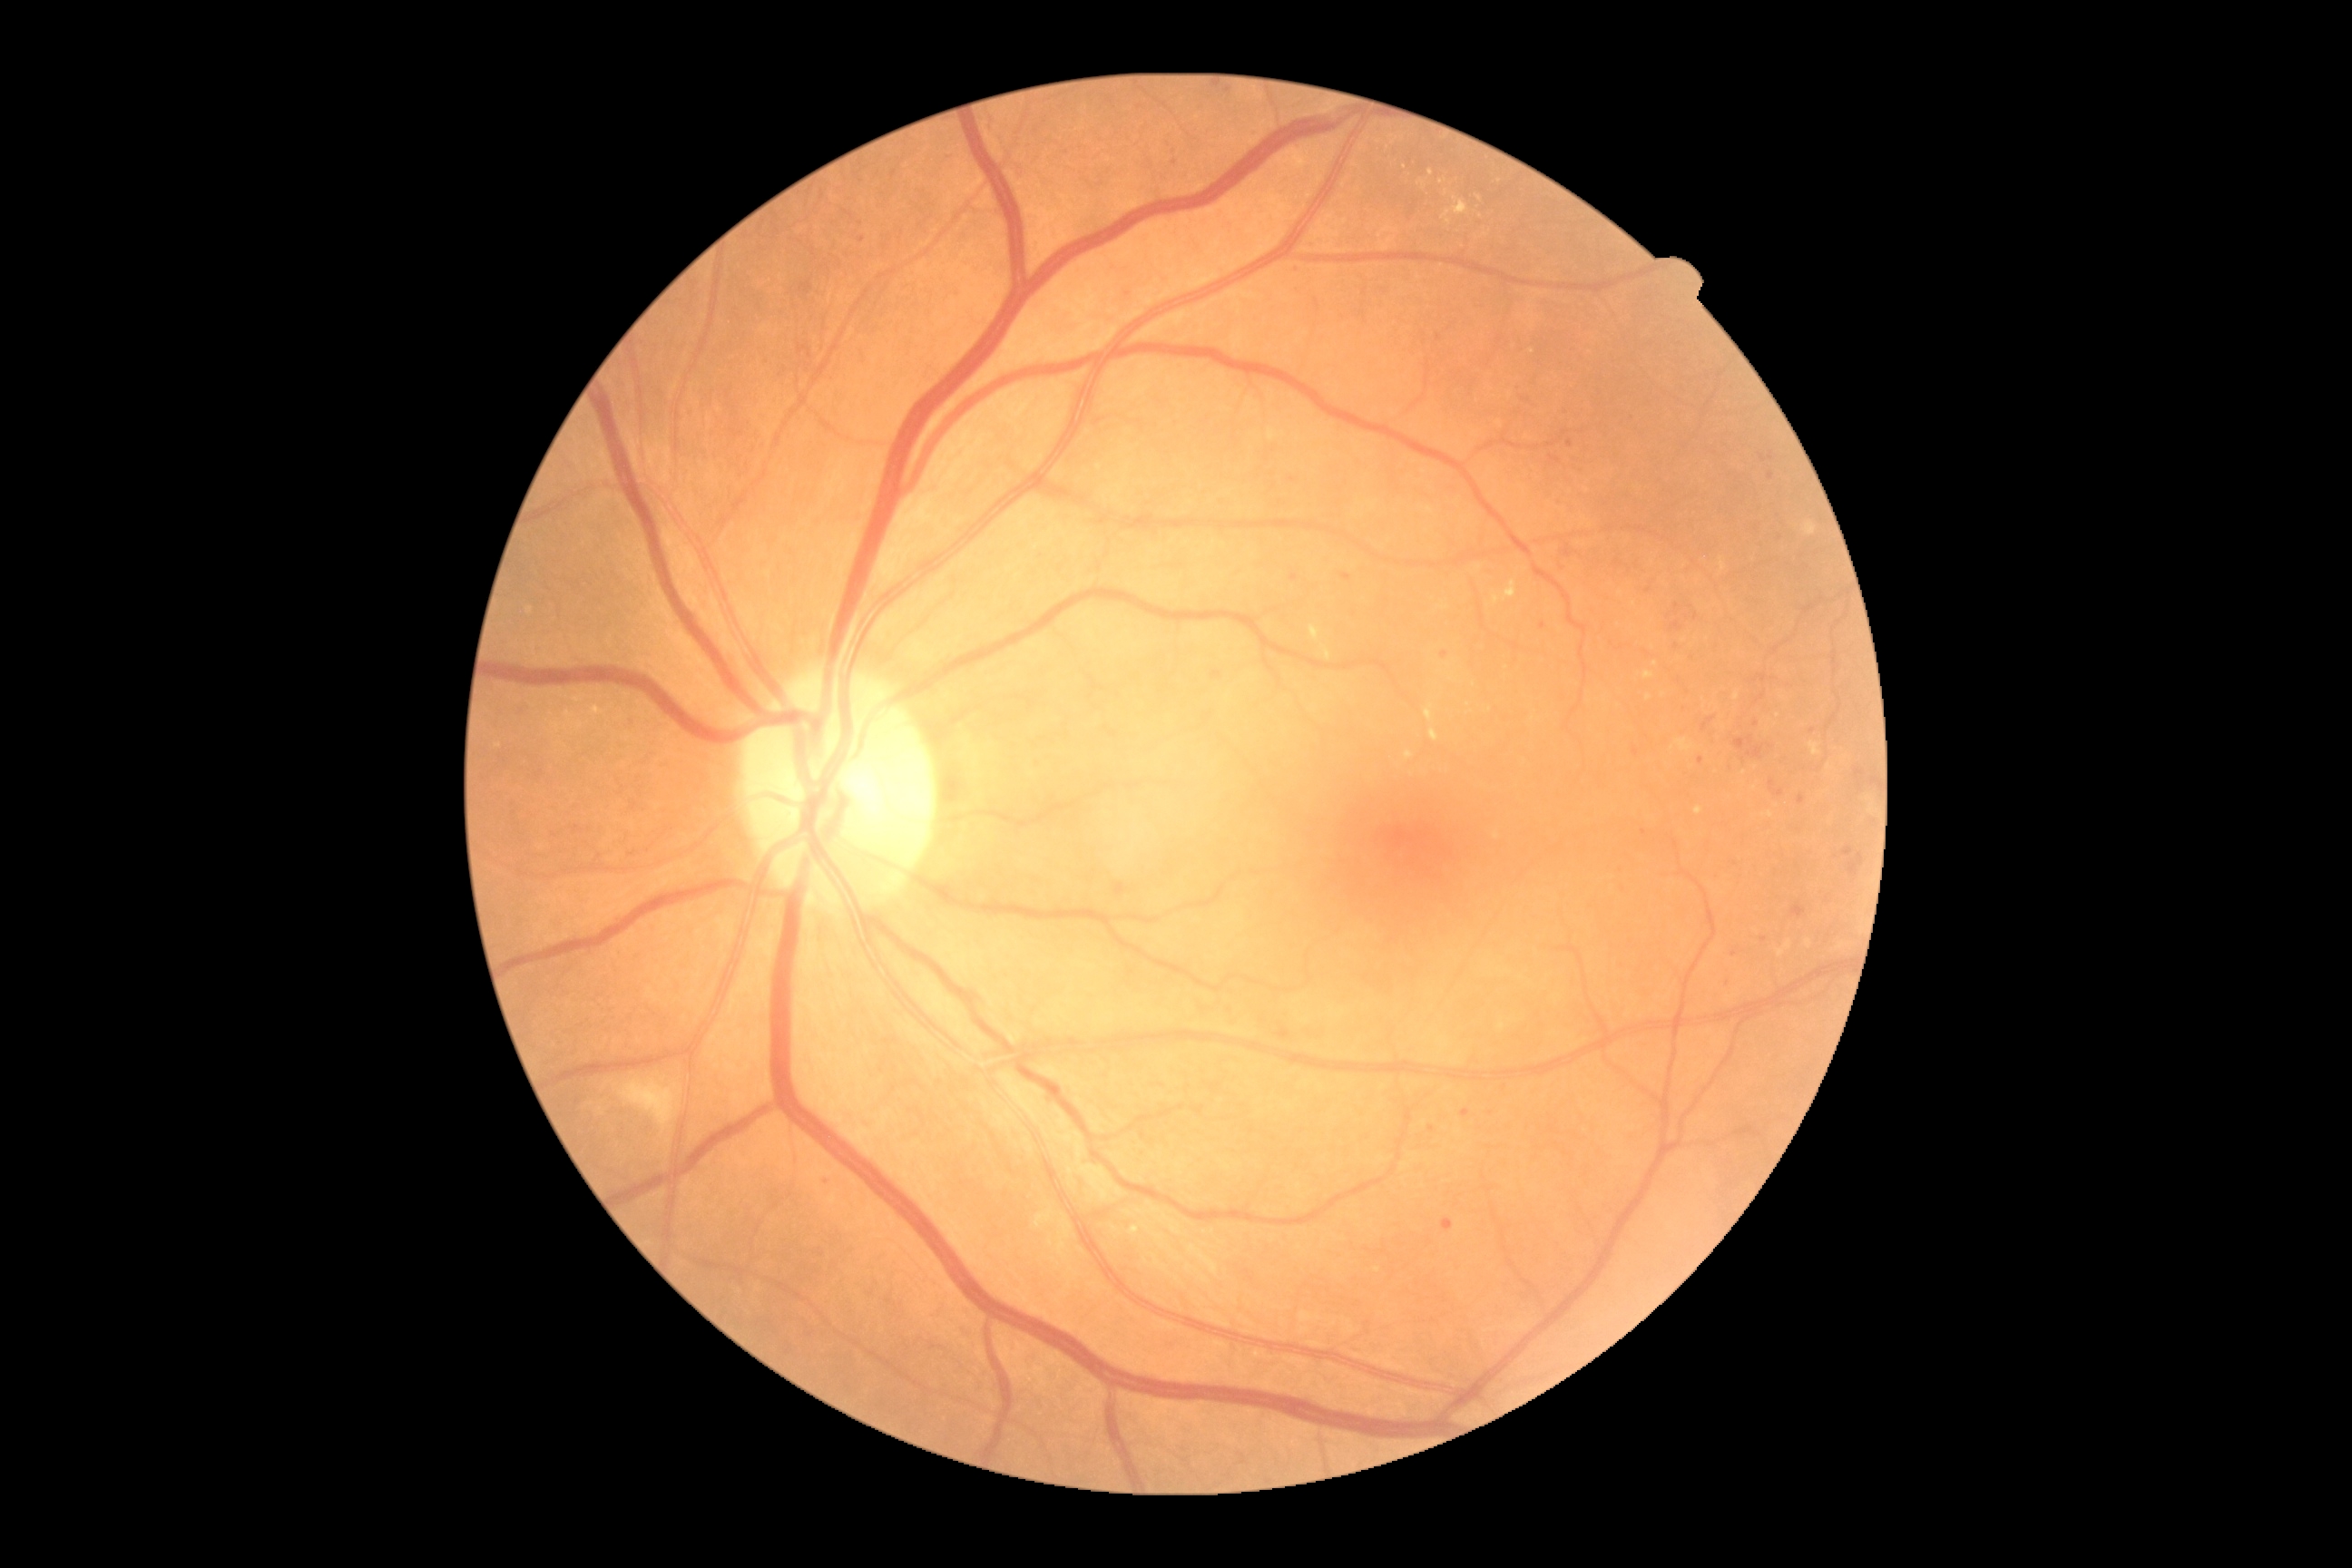

{"partial": true, "dr_grade": 2, "lesions": {"ex": [[1778, 941, 1792, 957], [1418, 181, 1426, 184], [1493, 580, 1516, 605], [1696, 807, 1703, 816], [1808, 741, 1821, 758], [1406, 752, 1413, 760], [1324, 647, 1331, 660], [1130, 1226, 1139, 1235], [1426, 705, 1433, 721]], "ex_small": [[1442, 182], [1480, 198], [1649, 697], [1657, 664], [1663, 696]], "he": null, "se": [[620, 1081, 680, 1132]], "ma": [[1671, 622, 1681, 632], [1291, 574, 1298, 582], [1850, 863, 1857, 876], [1843, 848, 1854, 856], [1758, 674, 1767, 681], [1701, 718, 1714, 732], [1857, 854, 1863, 863], [1734, 736, 1754, 750], [1856, 770, 1865, 779]], "ma_small": [[1764, 459], [1644, 833], [1765, 941], [862, 241], [1771, 458], [1175, 163]]}}